DR severity per modified Davis staging; NIDEK AFC-230.
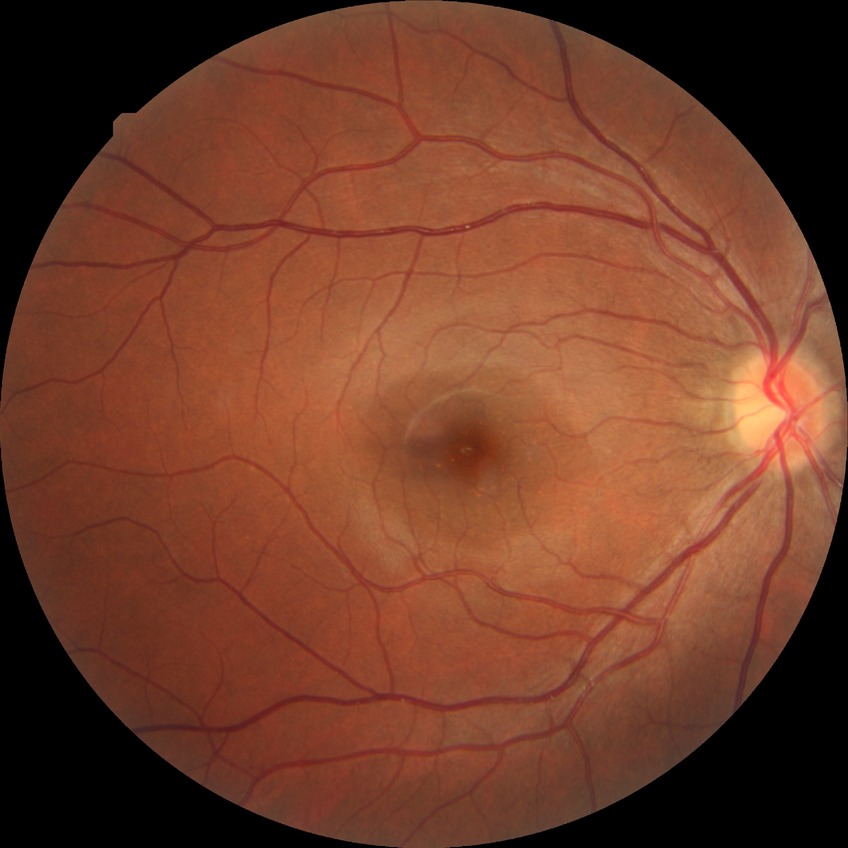 diabetic retinopathy (DR)@NDR (no diabetic retinopathy).